2212 x 1659 pixels · 45-degree field of view — 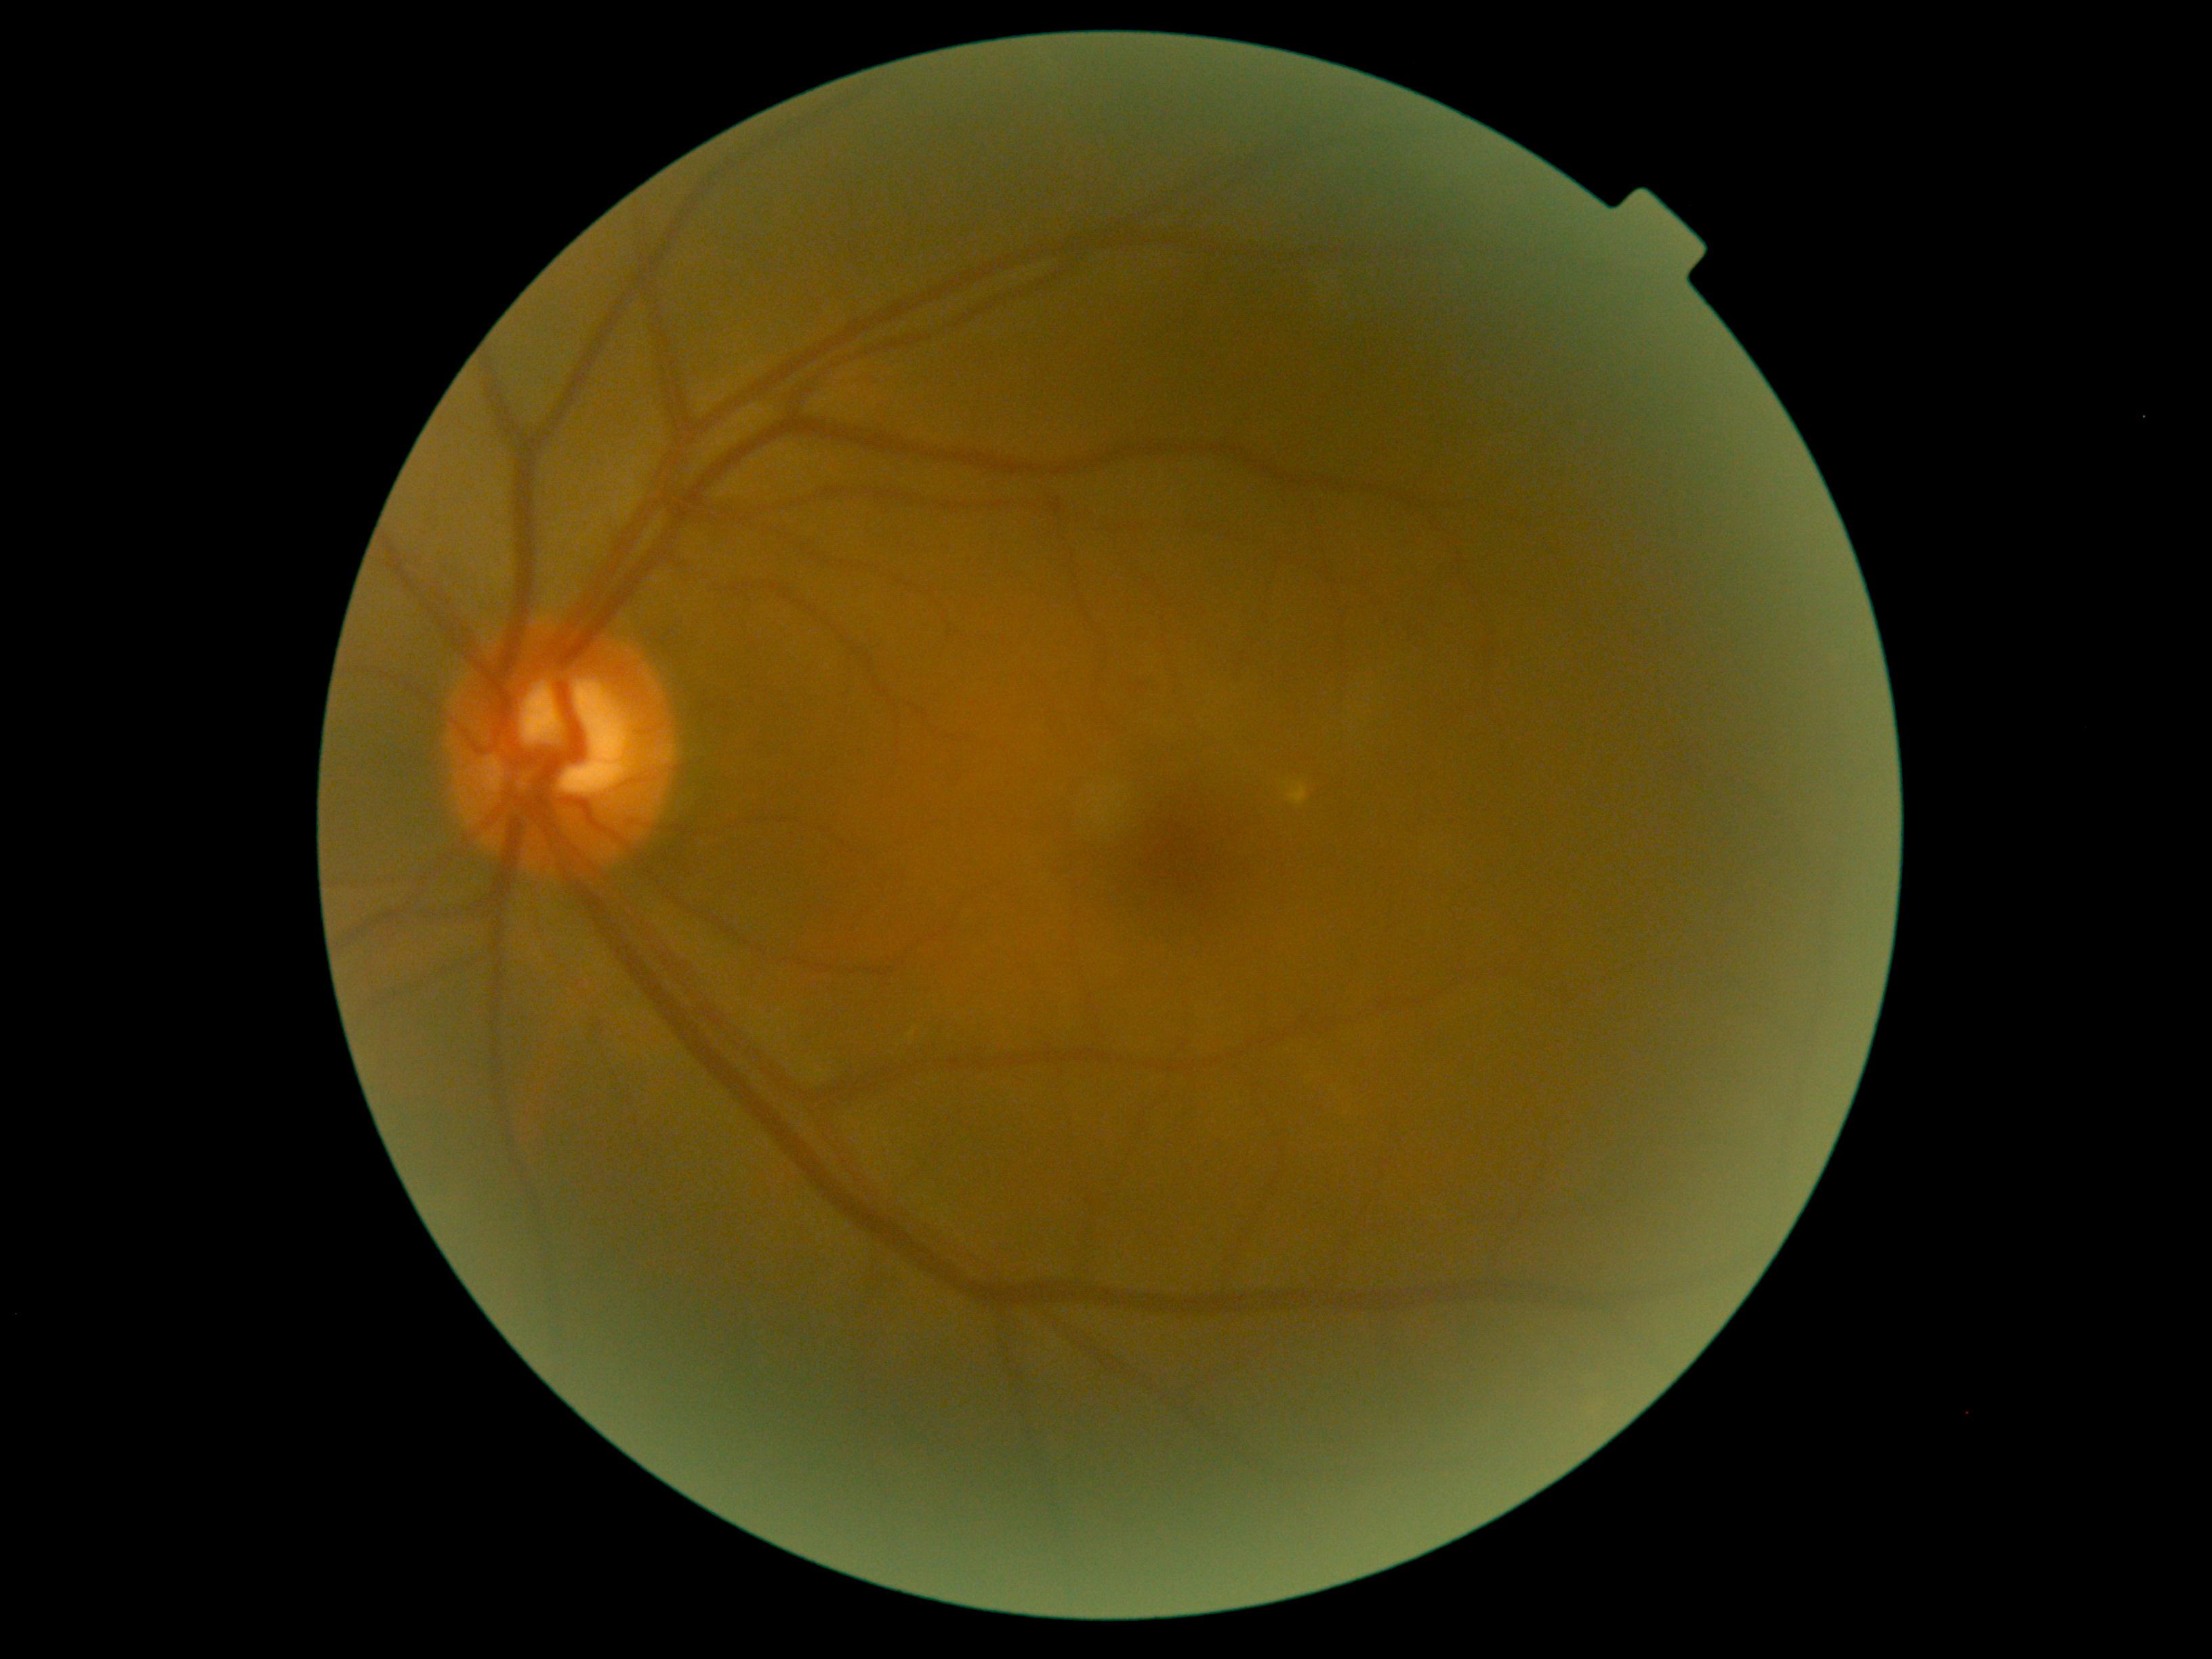
DR class: non-proliferative diabetic retinopathy.
Diabetic retinopathy (DR) is 2.